1725x1721:
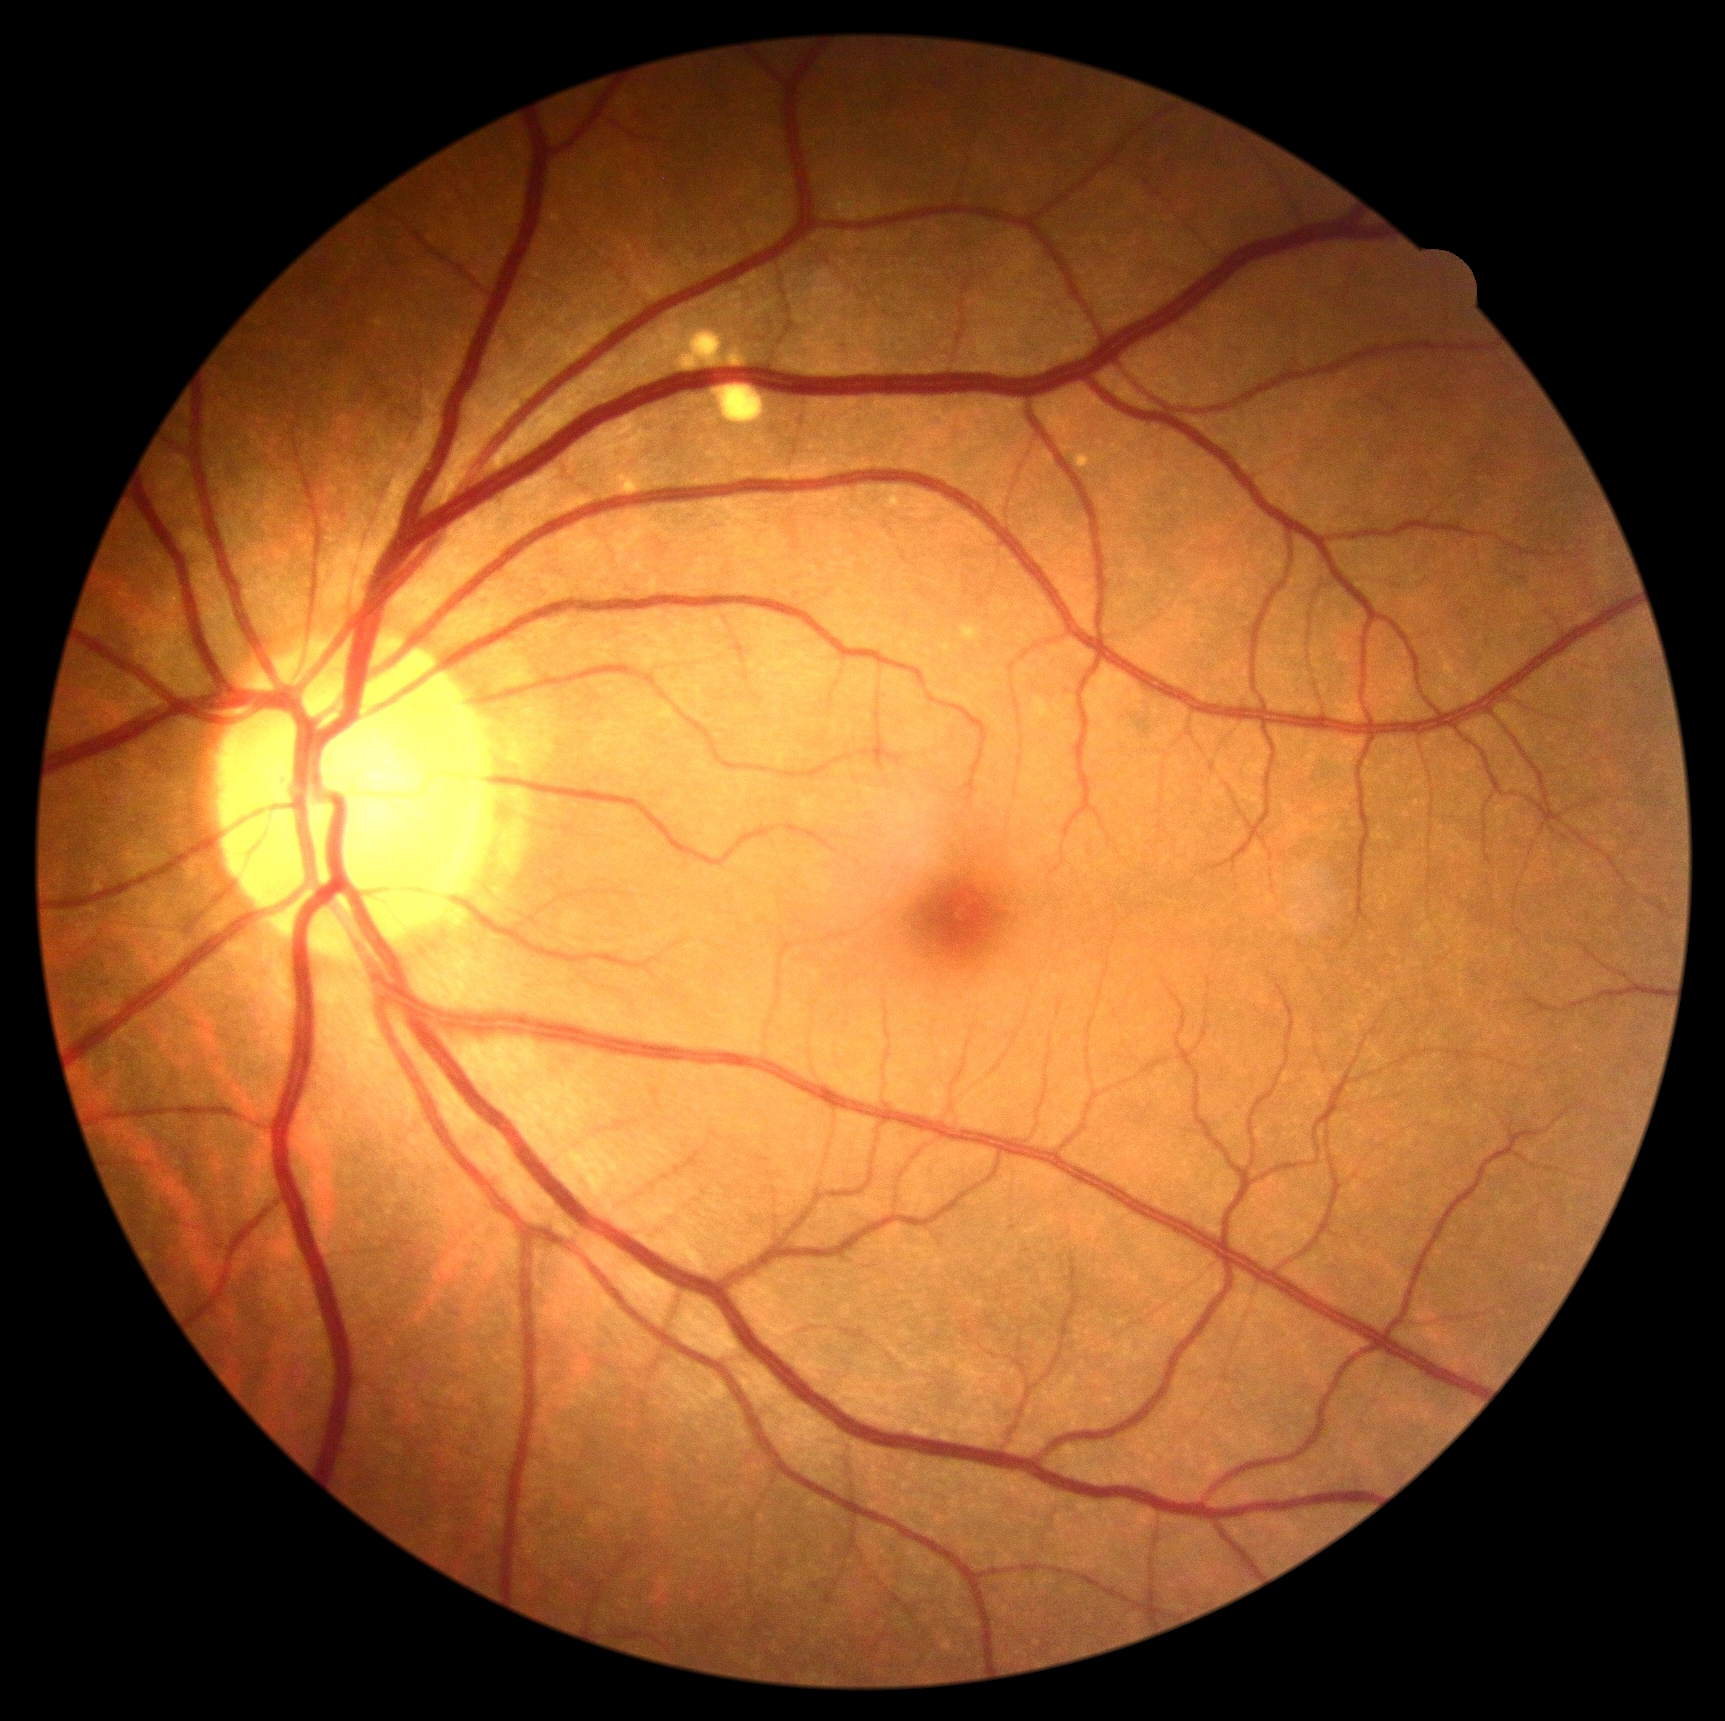

DR impression = negative for DR | DR = 0/4 — no visible signs of diabetic retinopathy.